Infant wide-field fundus photograph — 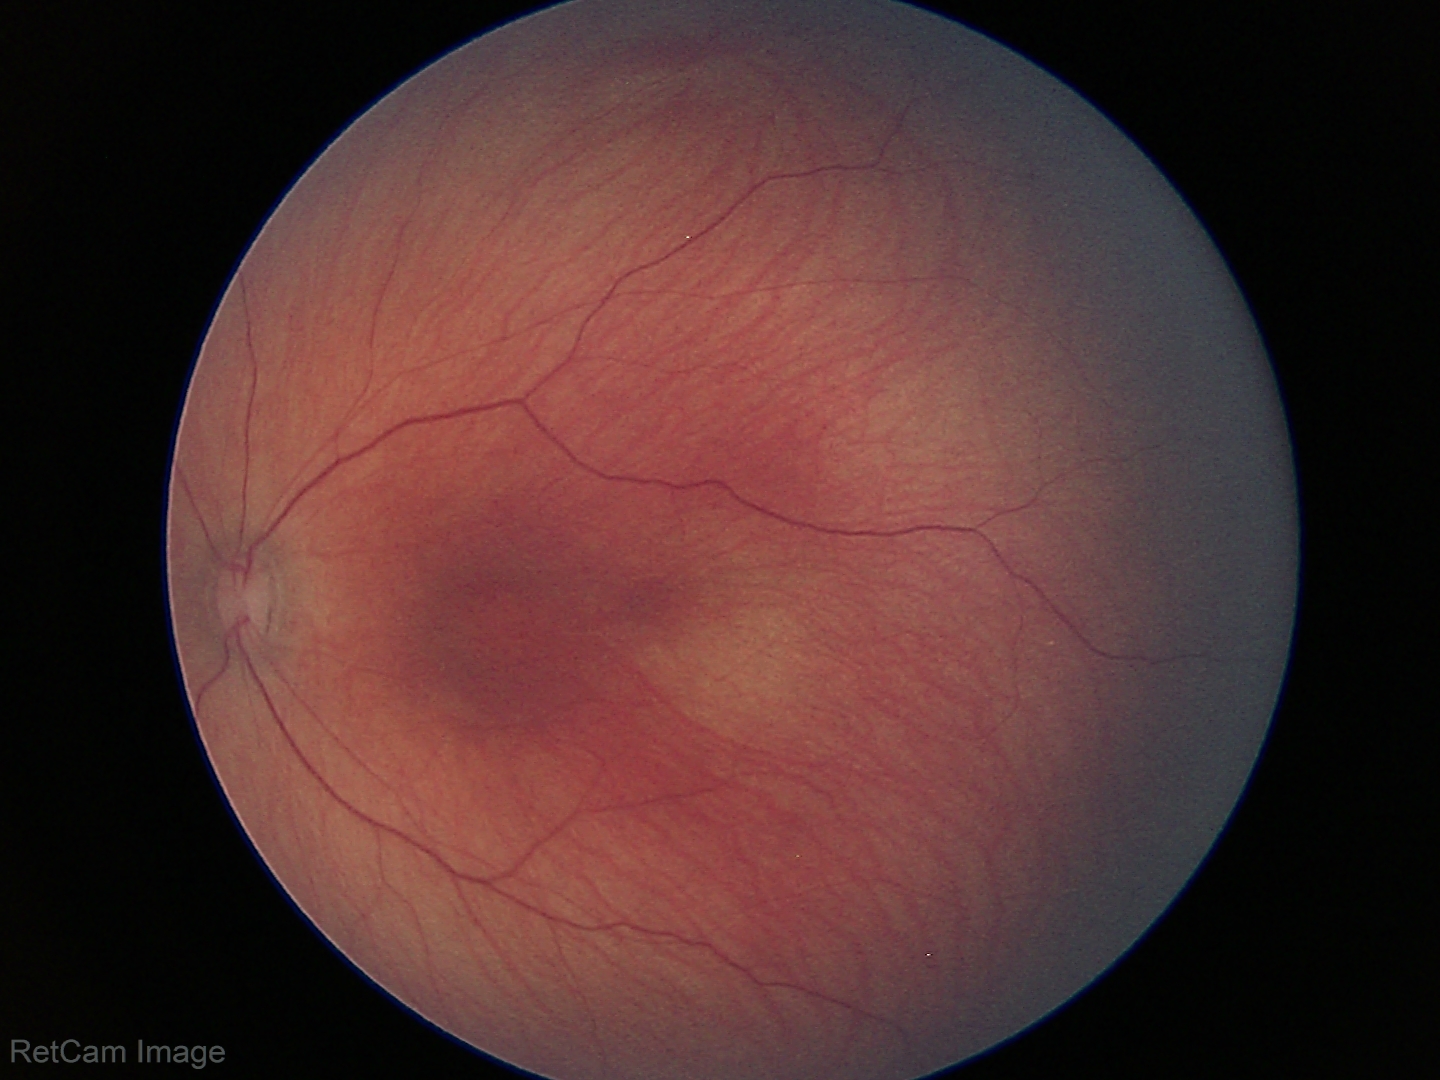
Physiological retinal appearance for postconceptual age.